45 degree fundus photograph
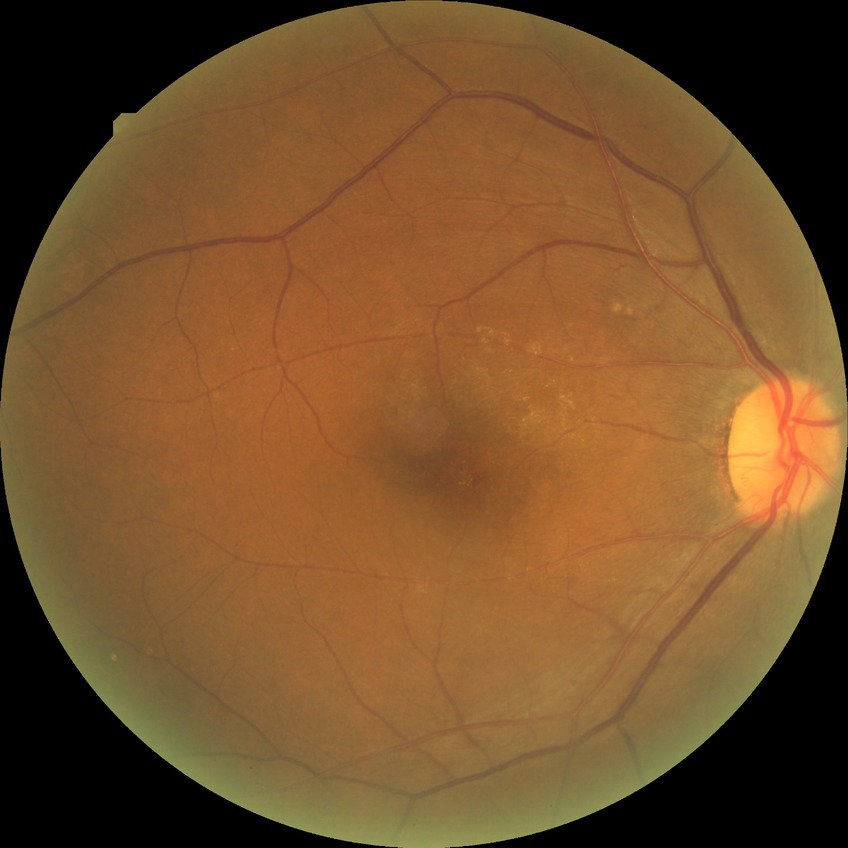

Diabetic retinopathy (DR): no diabetic retinopathy (NDR).